848 x 848 pixels. CFP. 45° field of view.
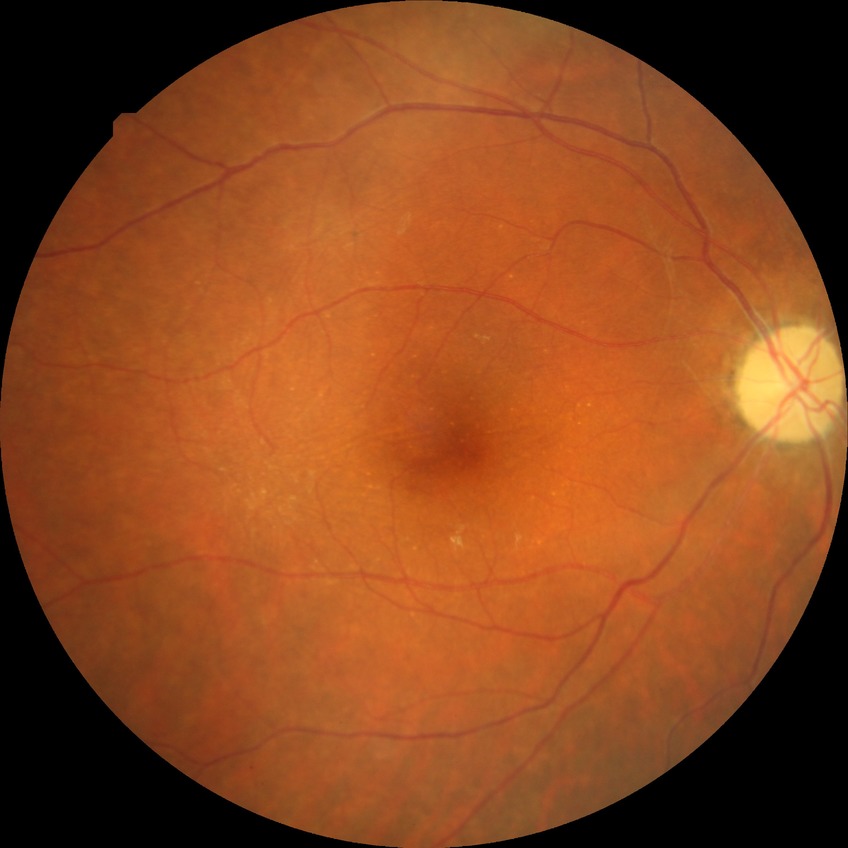
Modified Davis grading: no diabetic retinopathy.